1924 x 1556 pixels, FOV: 200 degrees, wide-field retinal mosaic image — 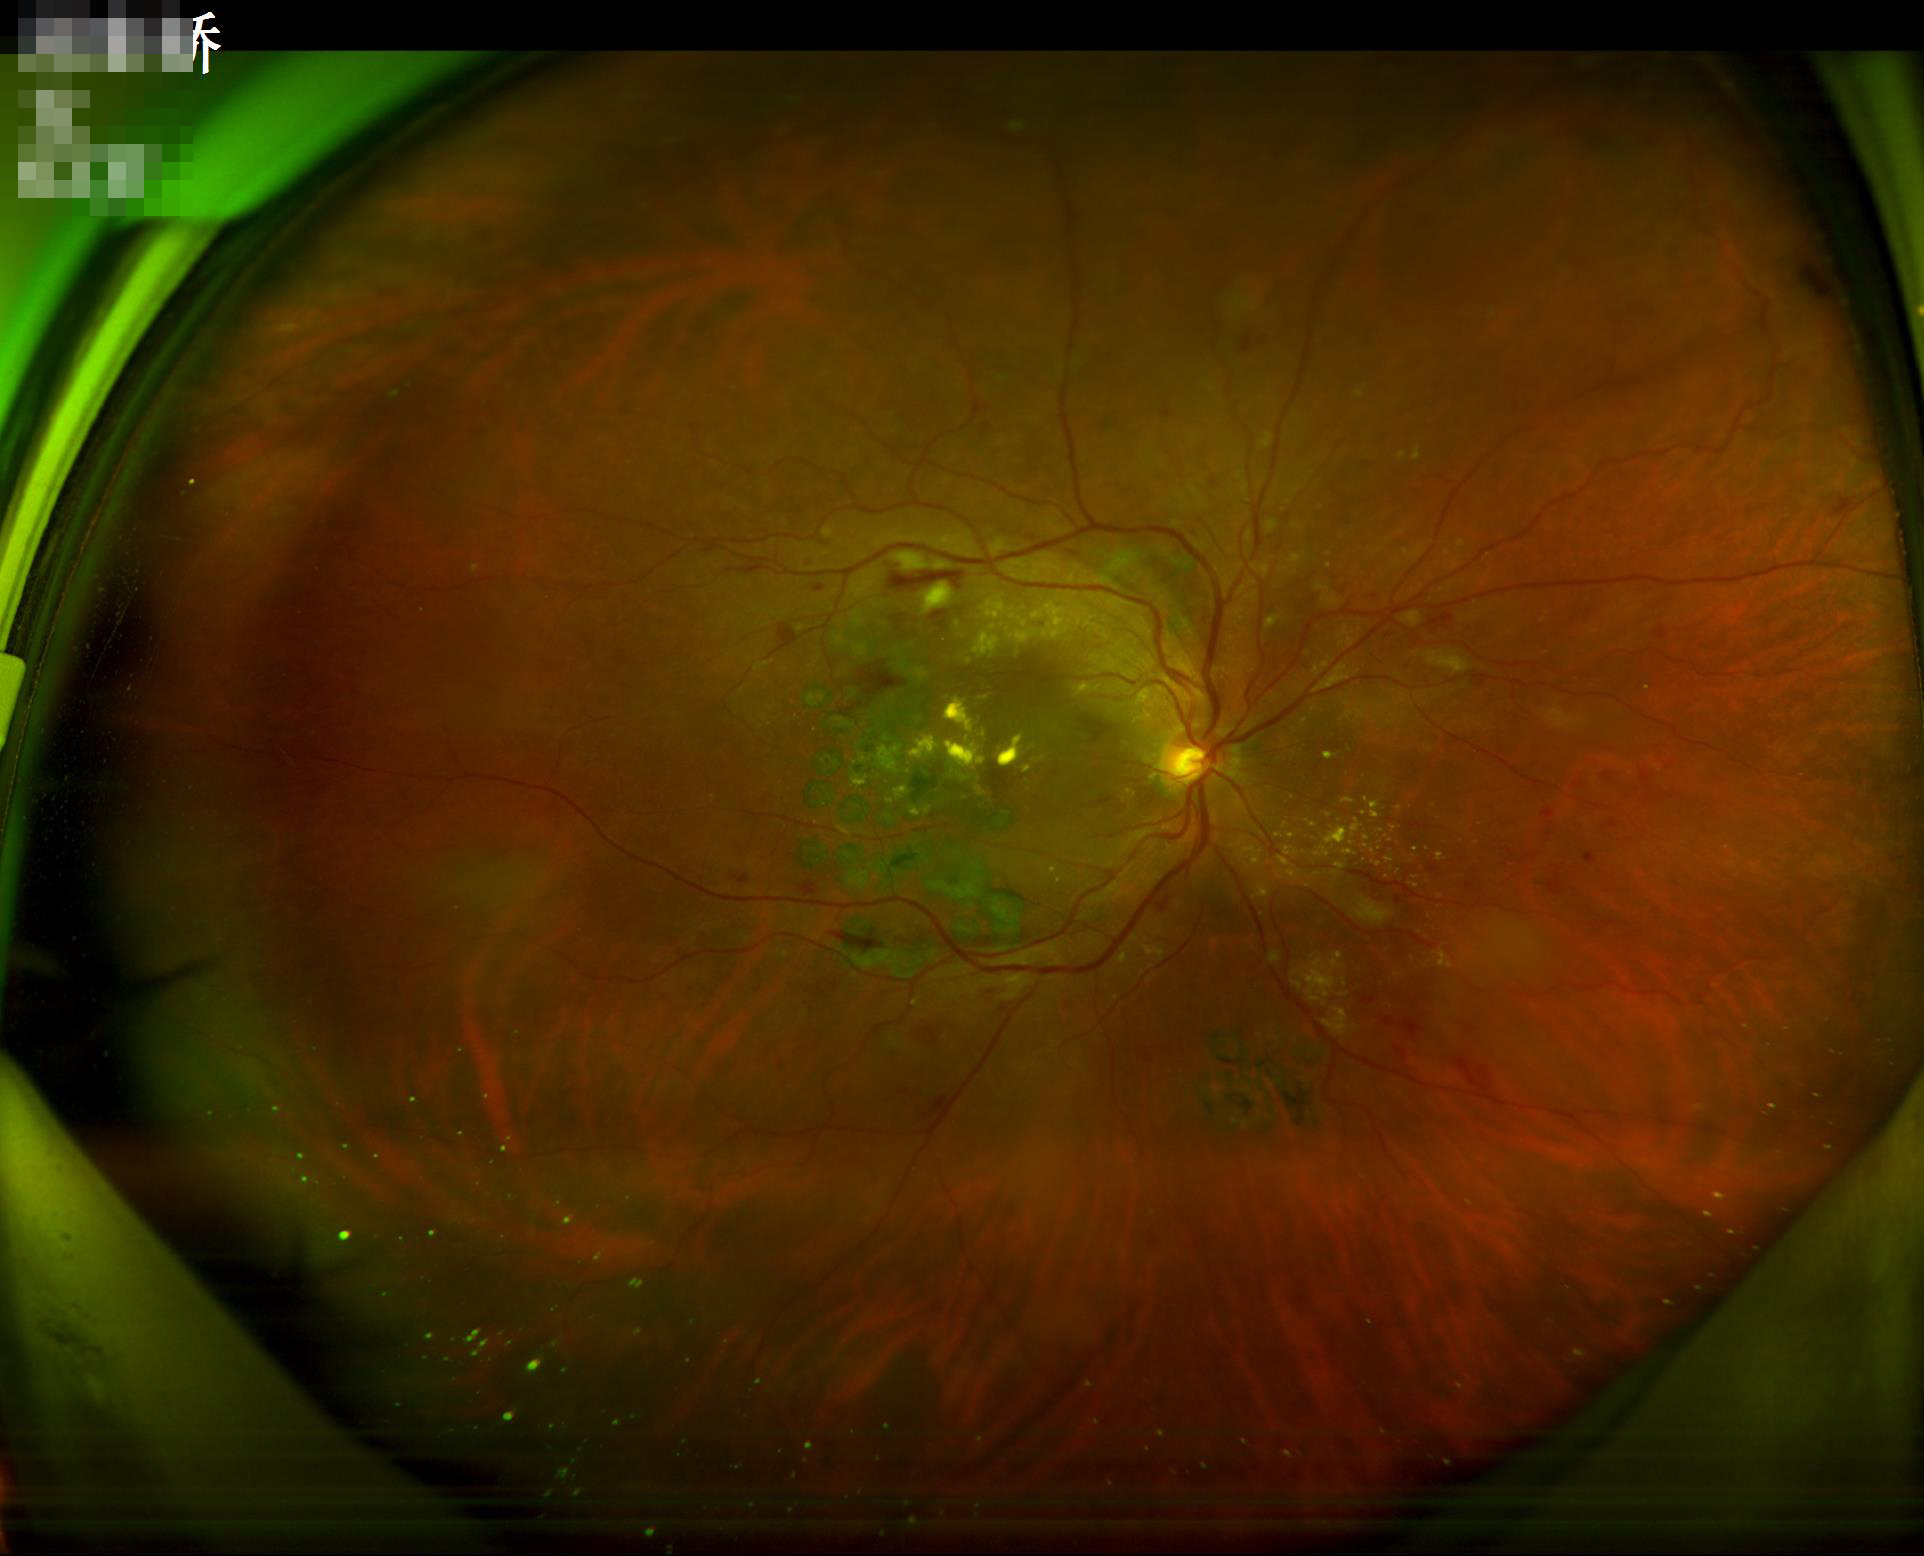
Quality assessment: contrast: satisfactory | illumination: even | overall: adequate.